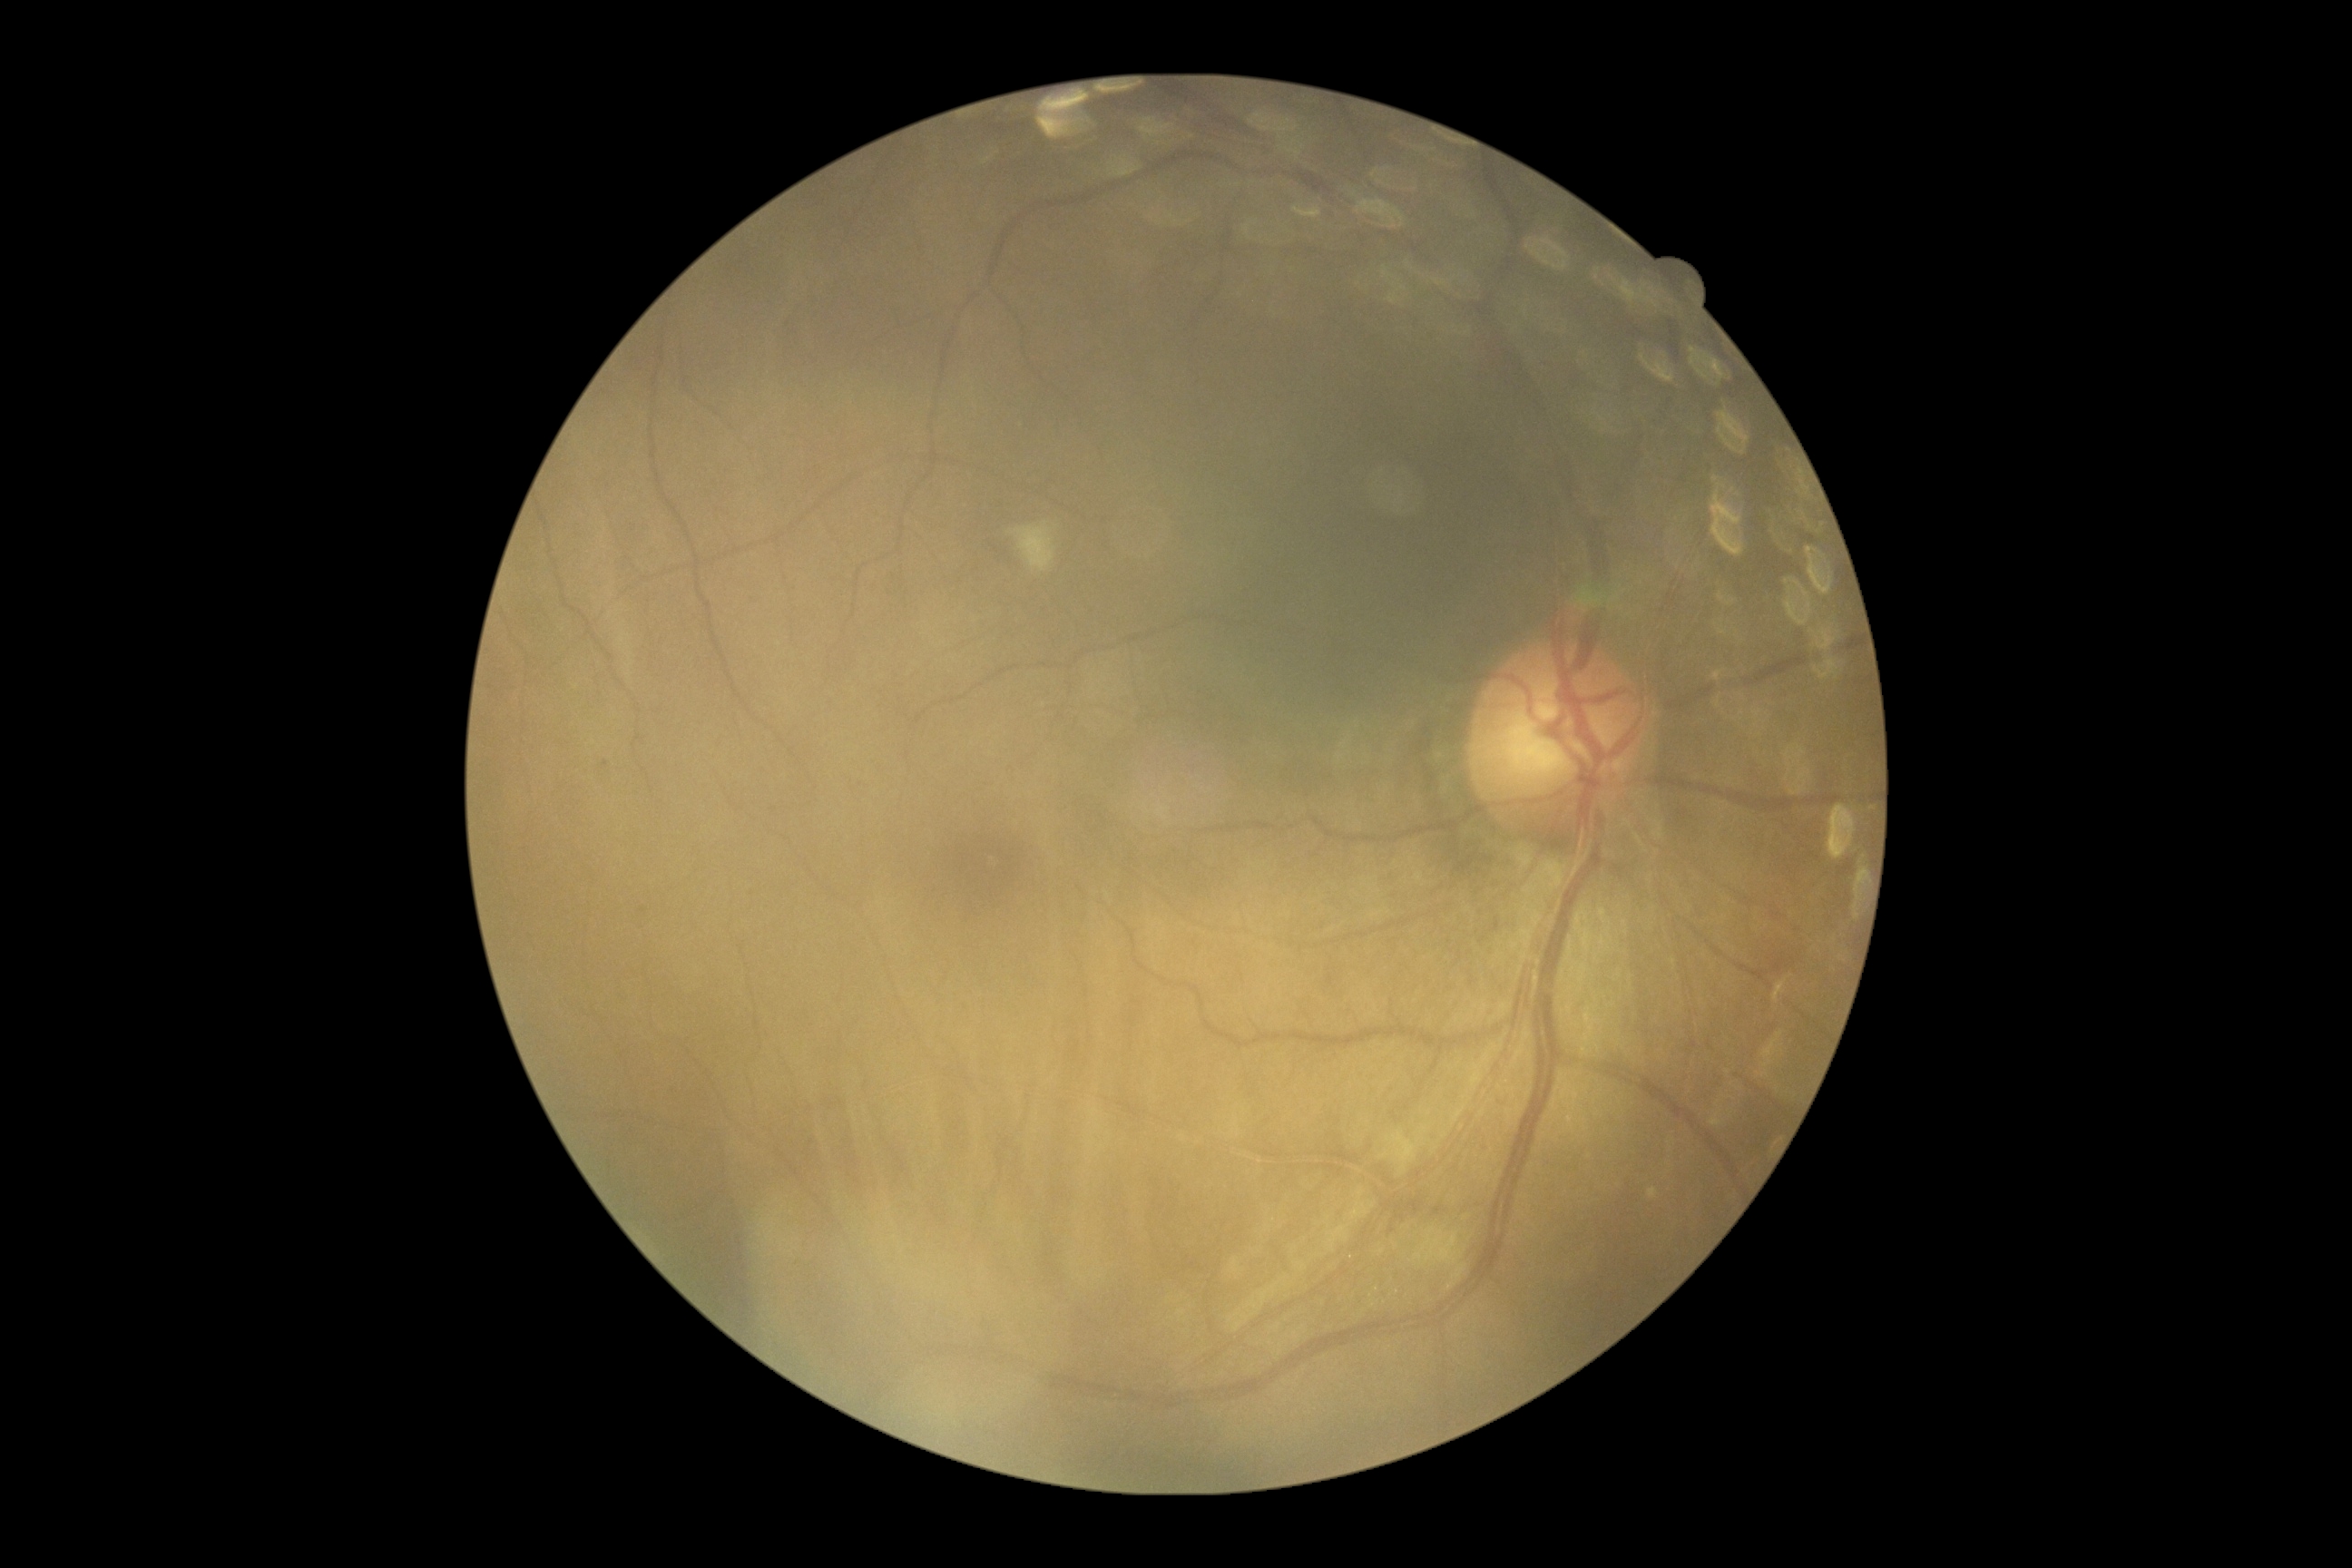

Retinopathy: grade 2.